Fundus photo taken with a portable handheld camera: 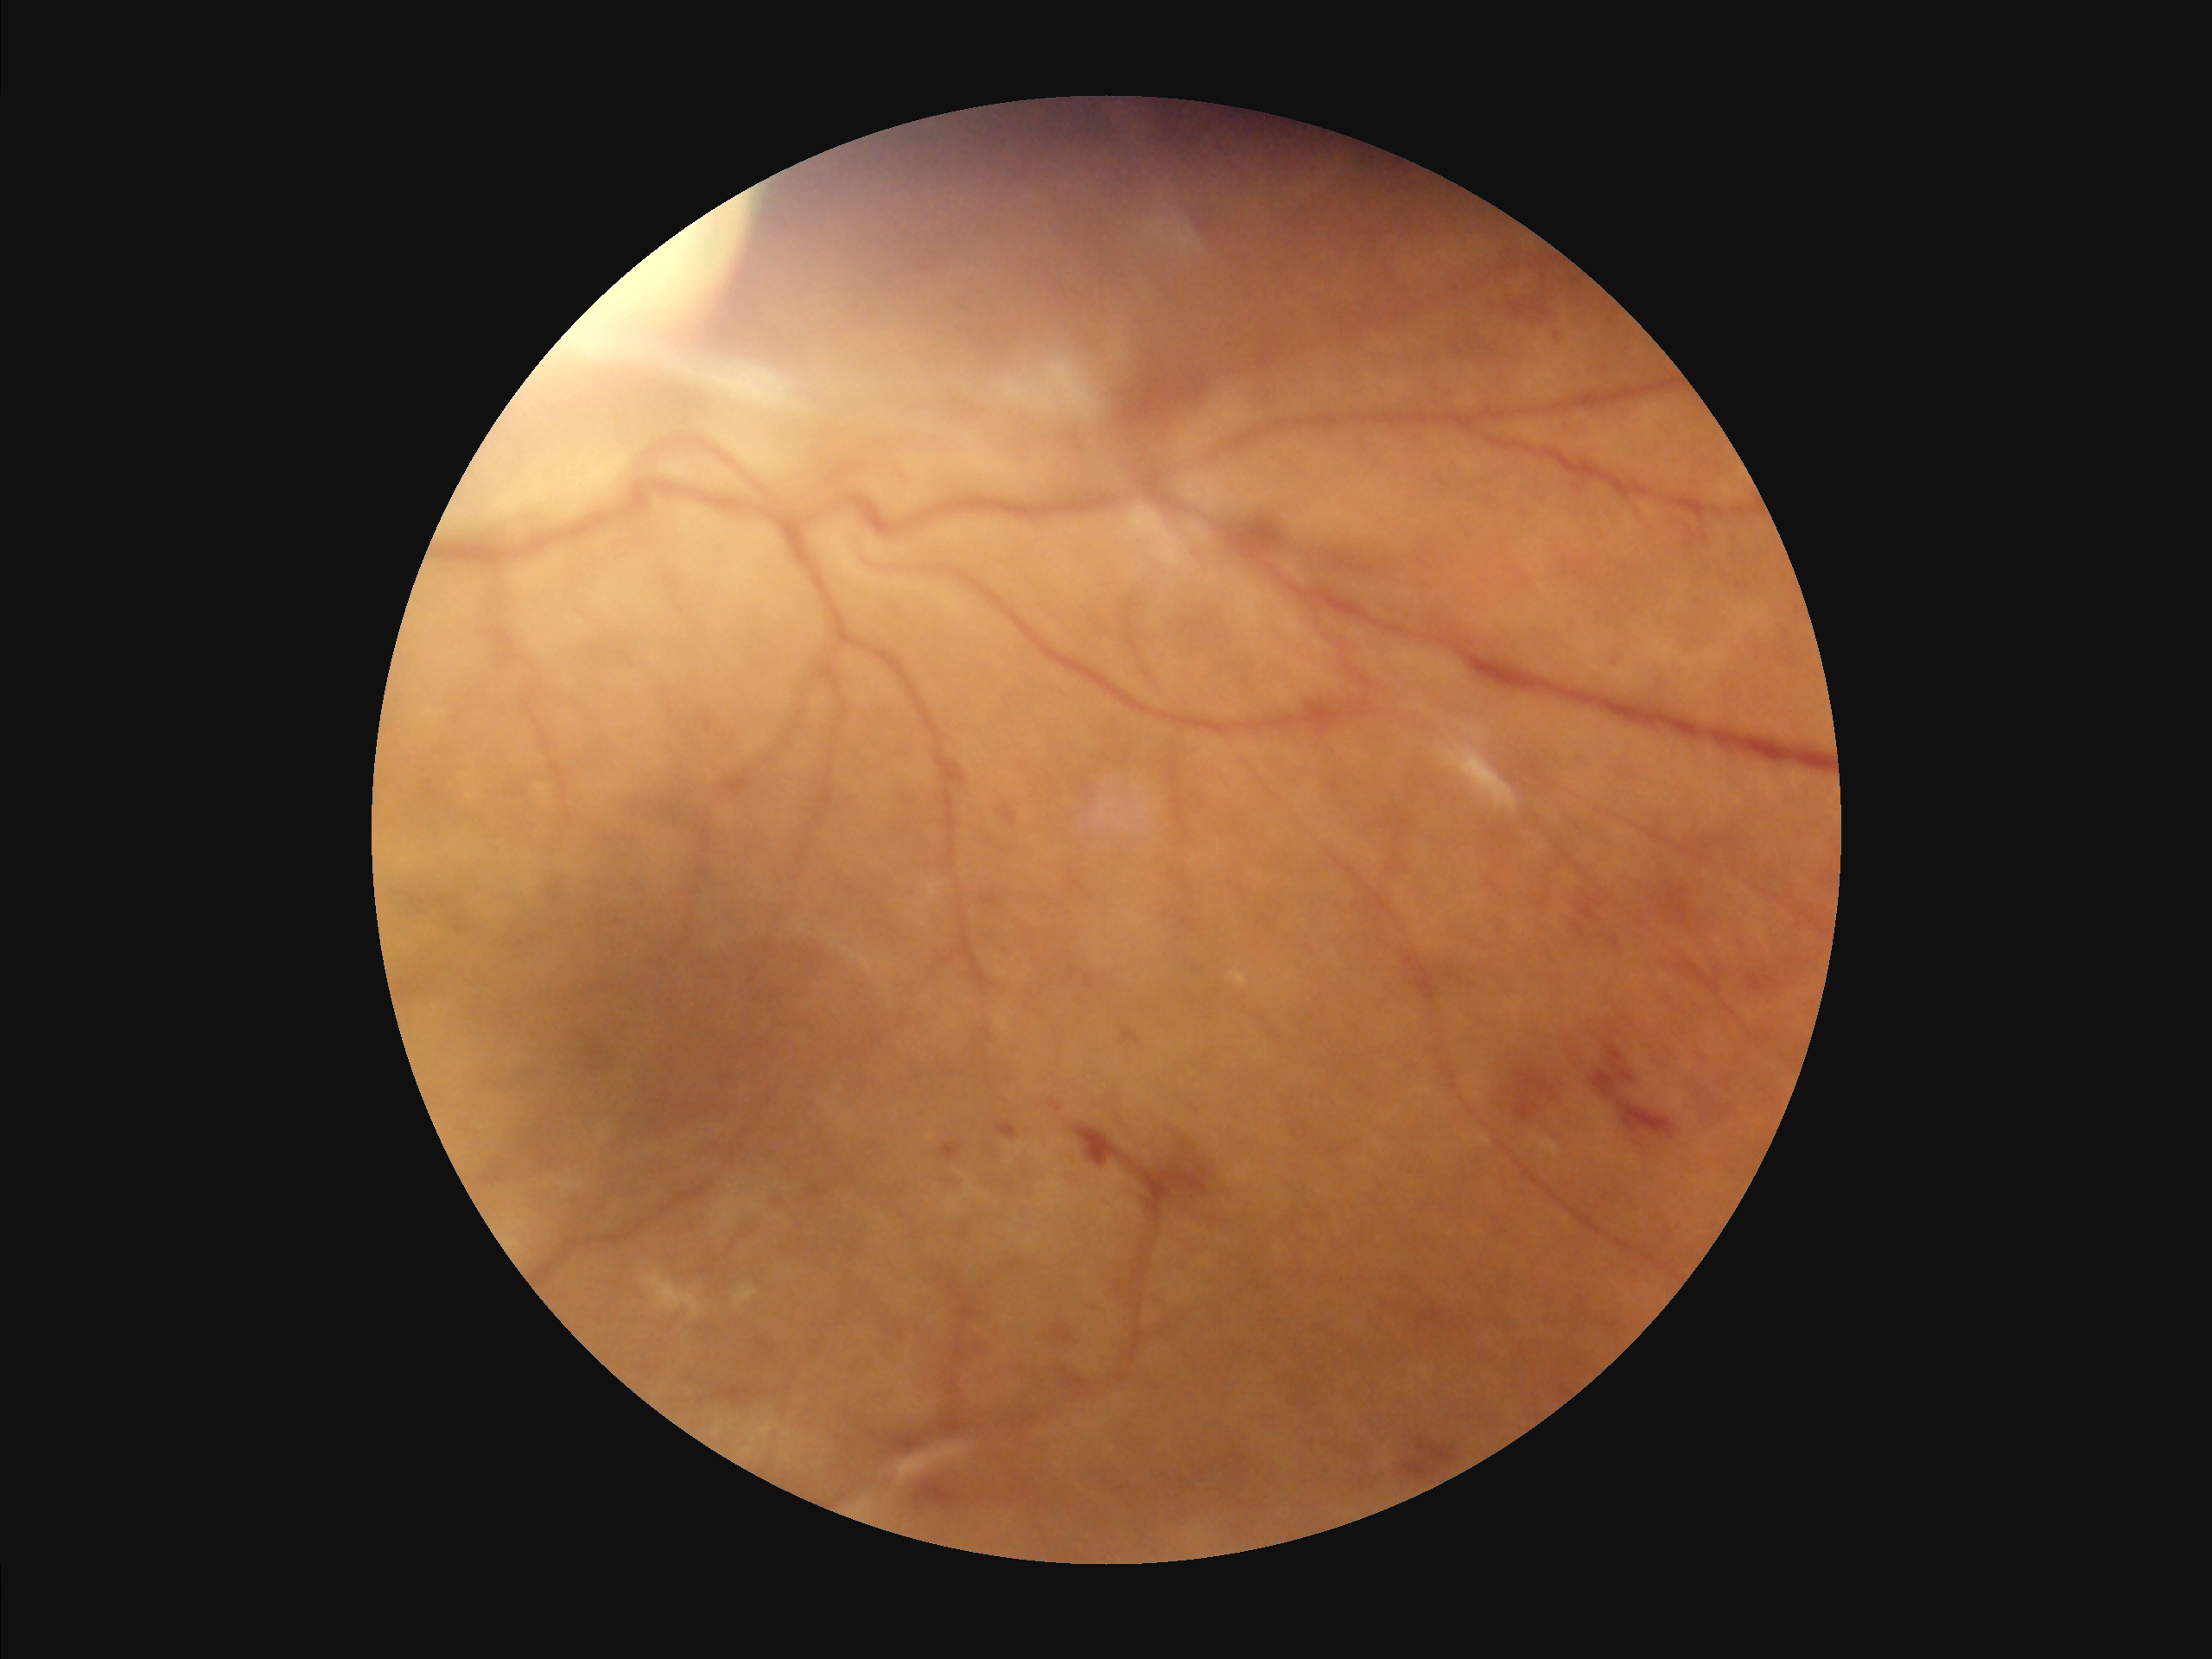 {"overall_quality": "satisfactory", "clarity": "poor", "illumination": "good", "contrast": "good"}